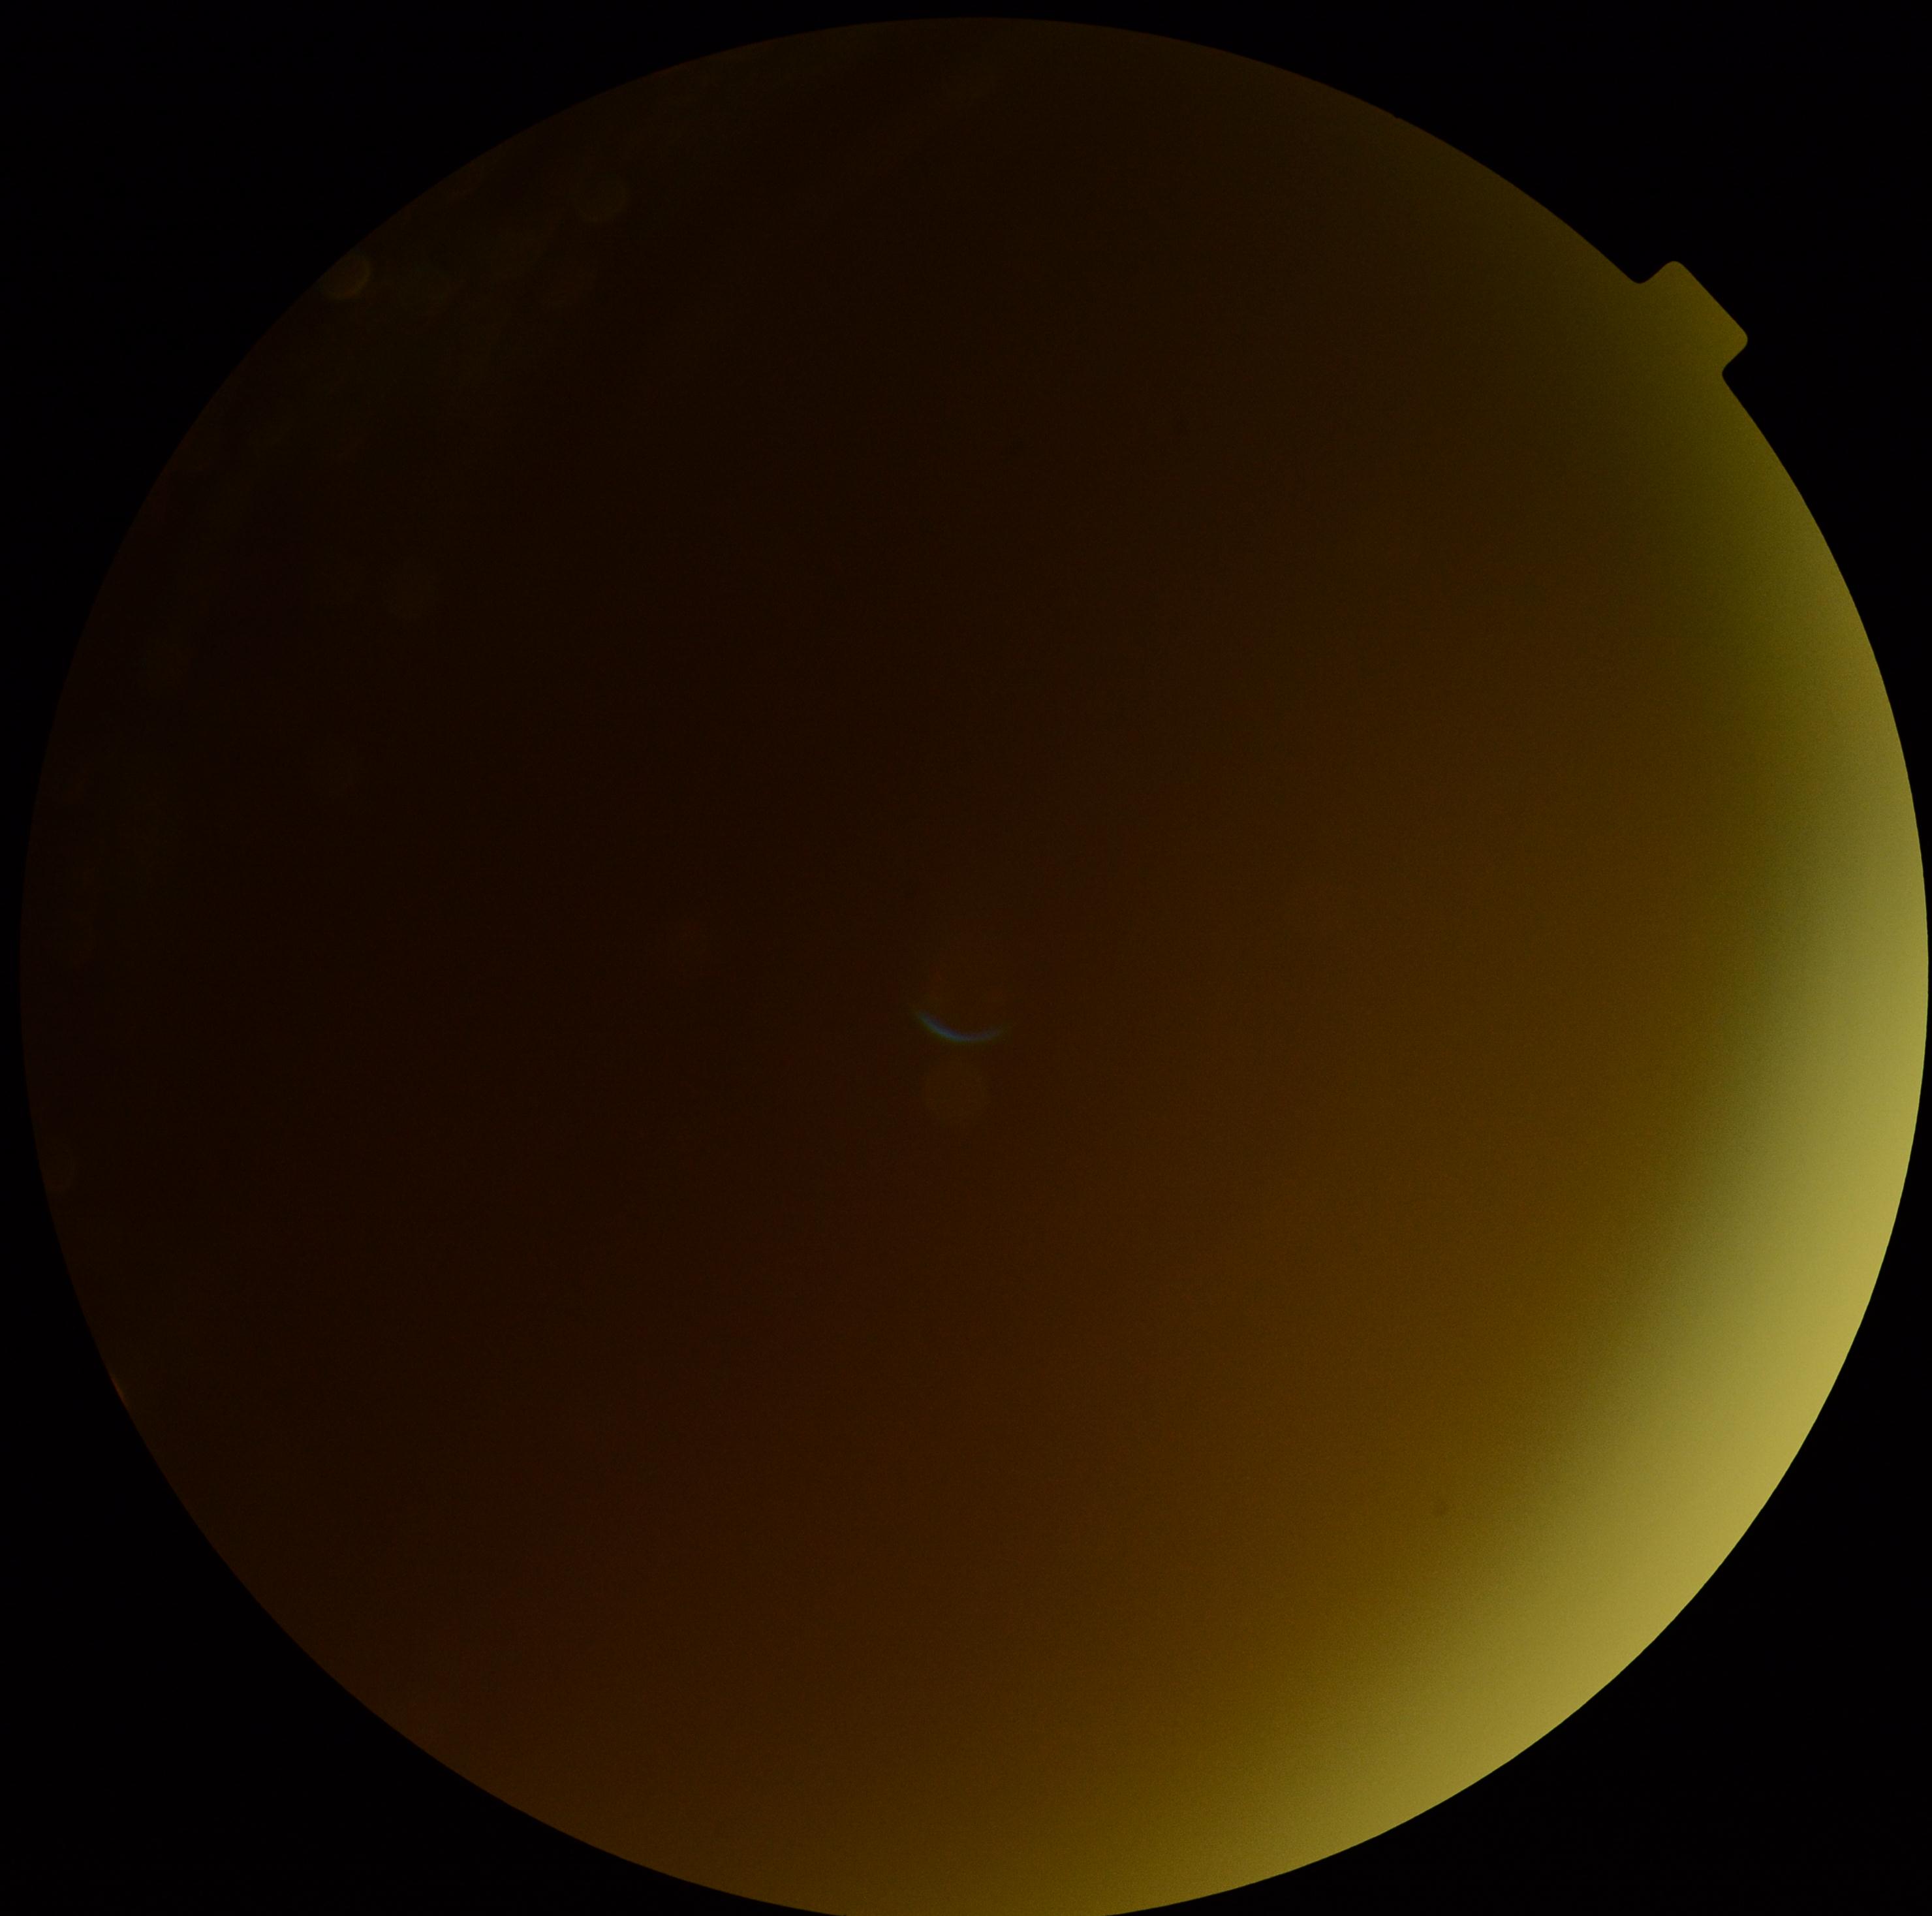
The image cannot be graded for diabetic retinopathy.
DR: ungradable.